Non-mydriatic acquisition; optic disc region crop; retinal fundus photograph: 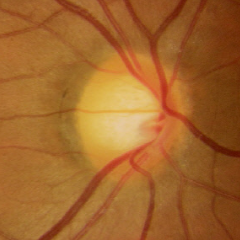
Impression = no glaucomatous changes.